DR severity per modified Davis staging
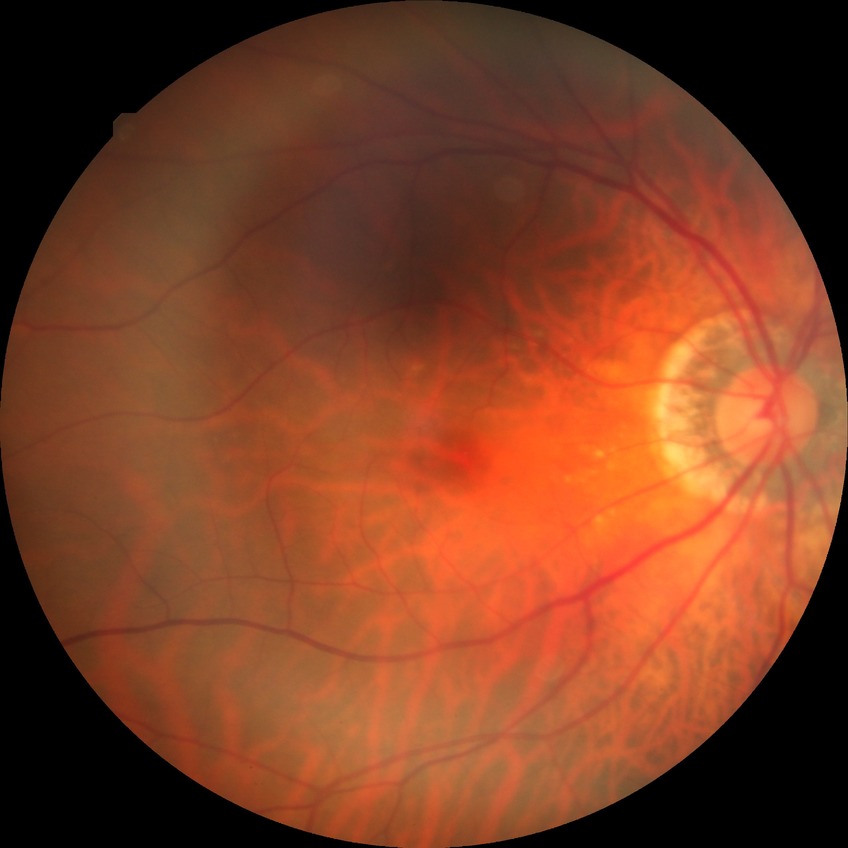 Diabetic retinopathy (DR): no diabetic retinopathy (NDR).